No pharmacologic dilation, 45-degree field of view.
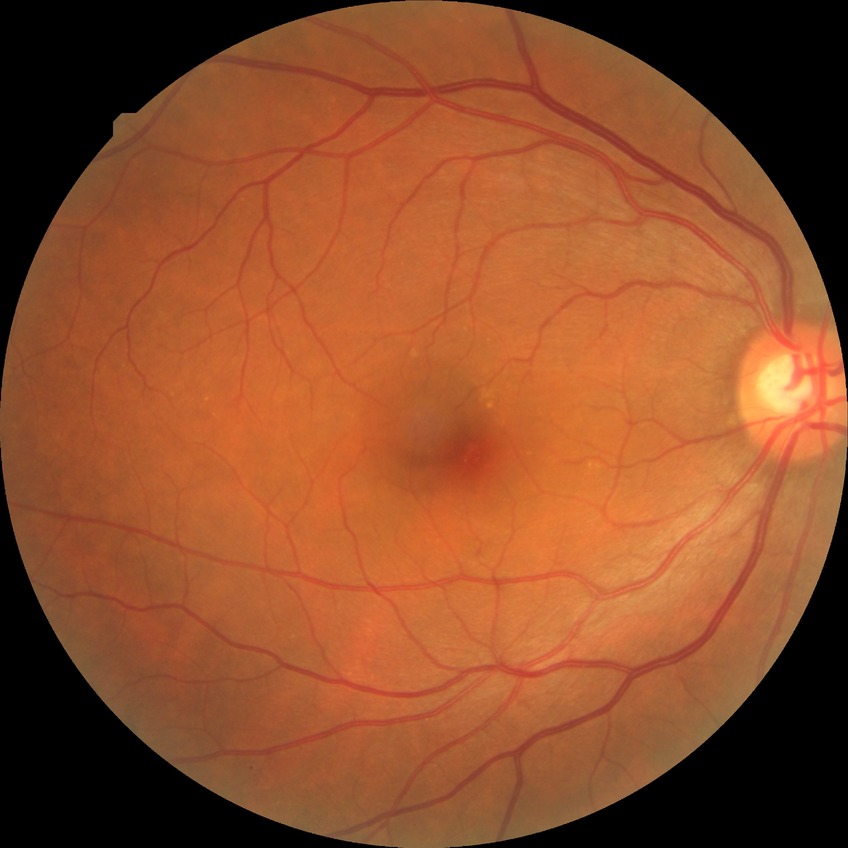
DR = NDR.